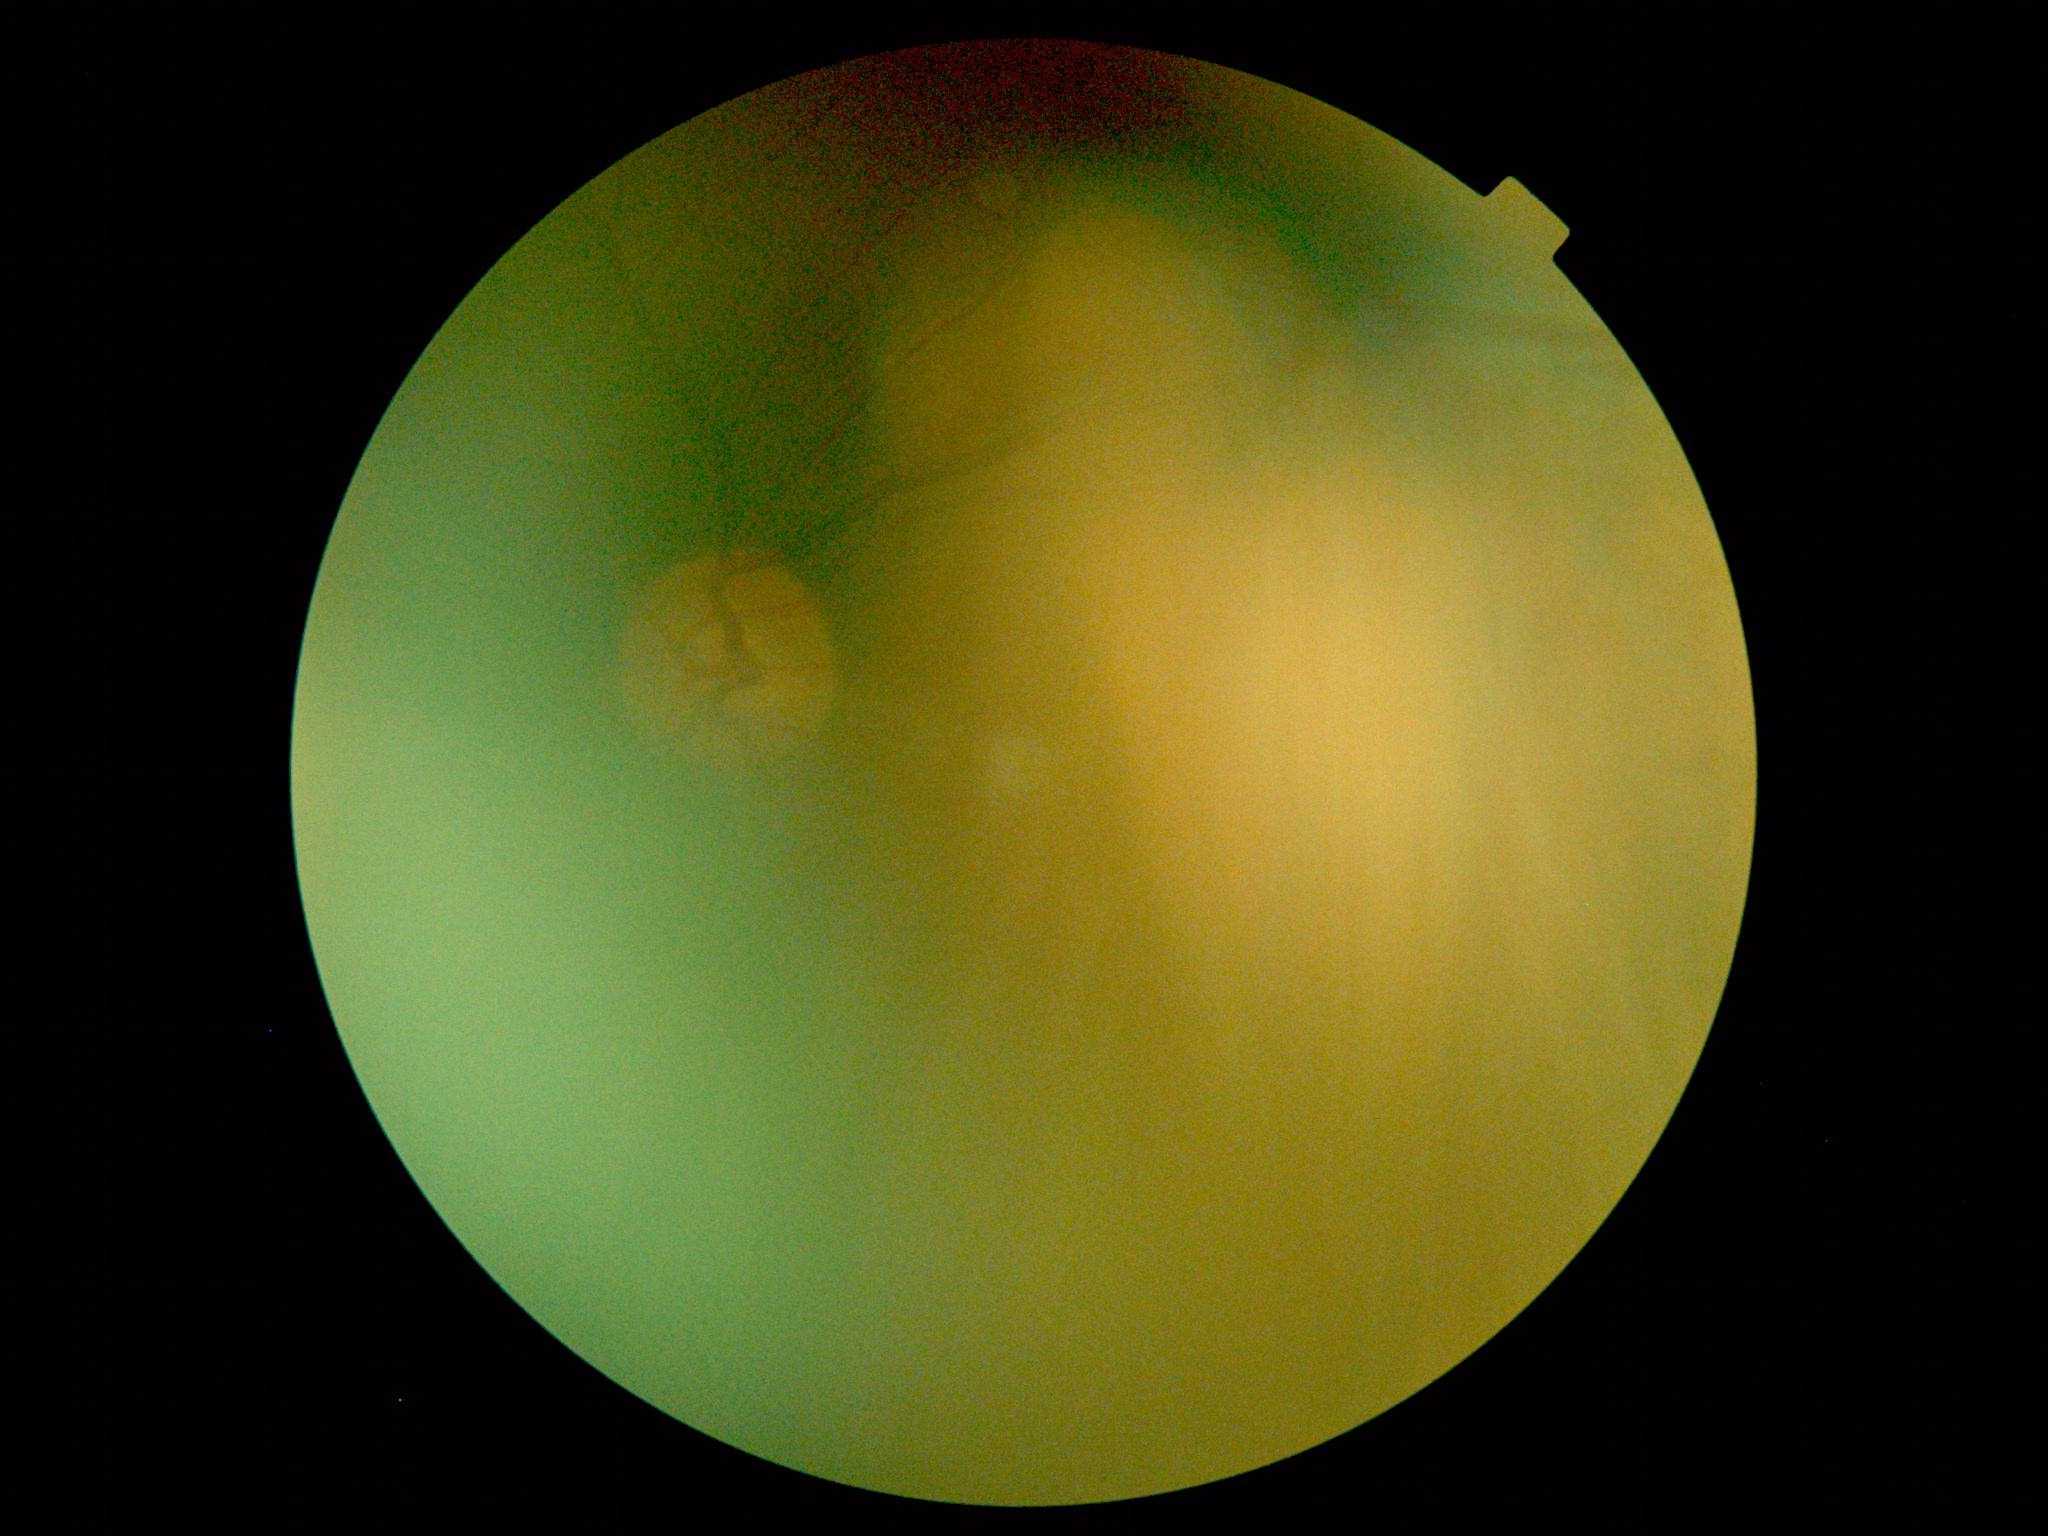

DR severity: ungradable due to poor image quality.